1659 by 2212 pixels: 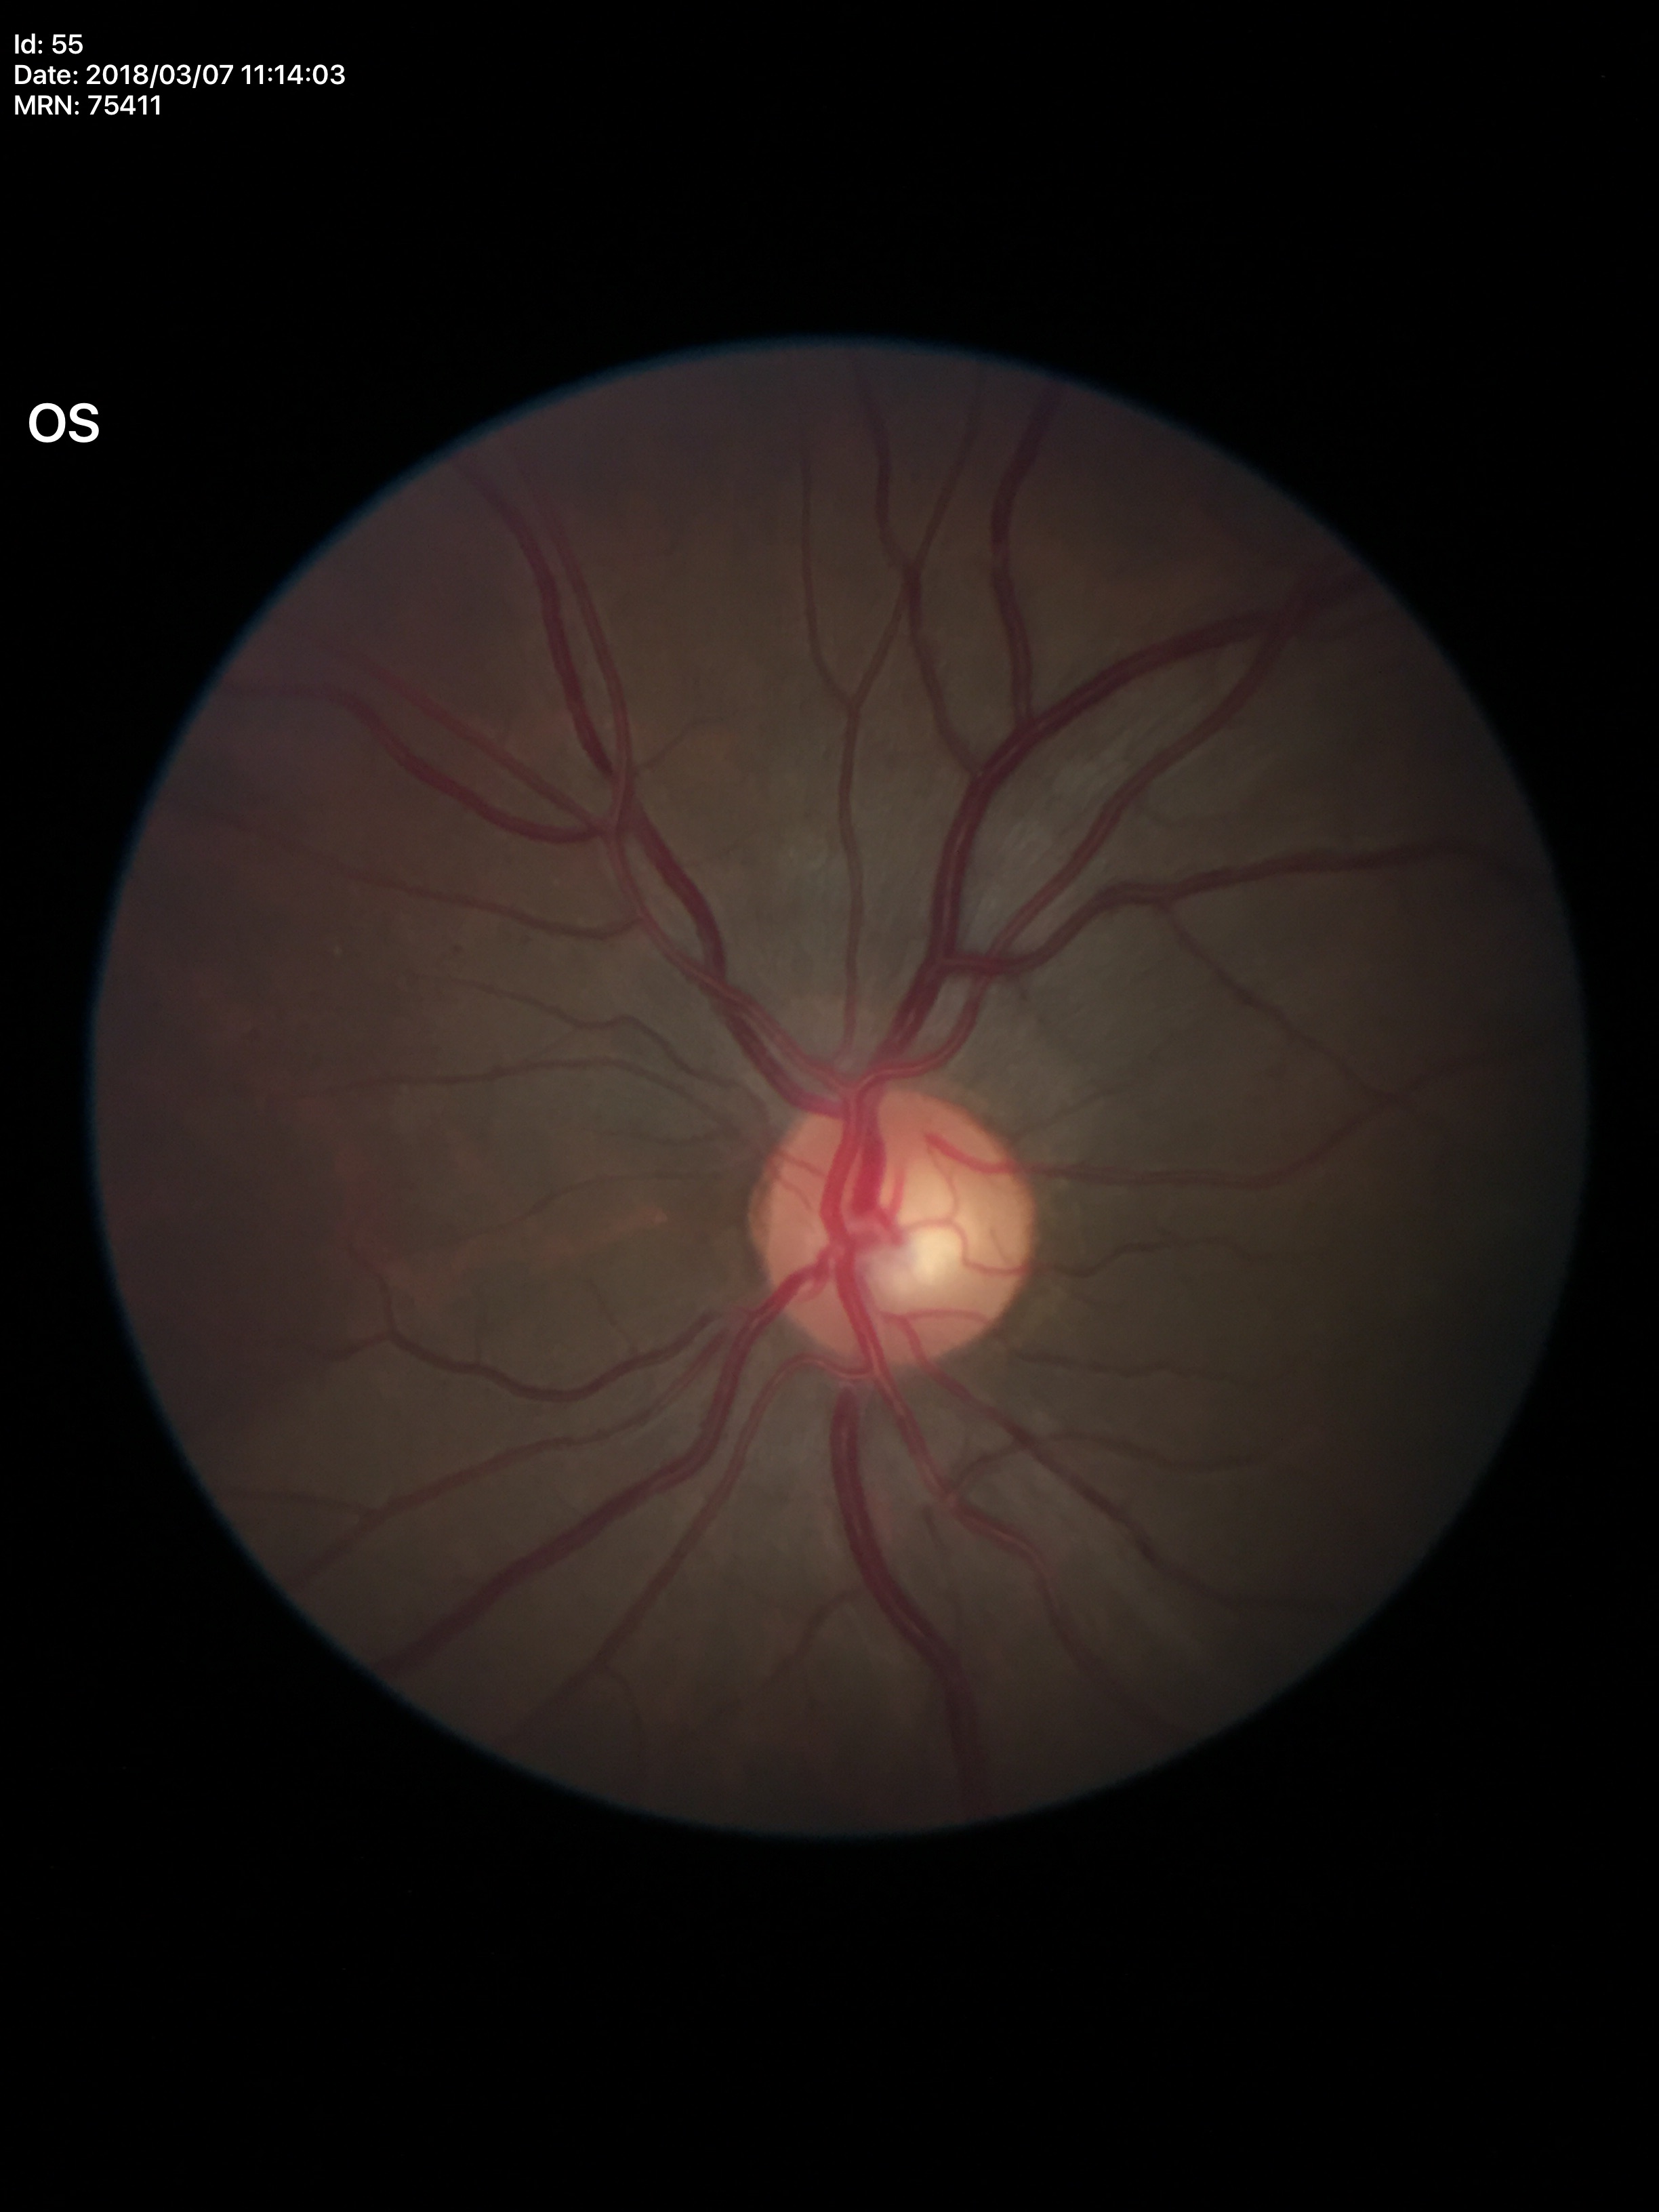
Glaucoma evaluation: no suspicious findings, vertical cup-disc ratio: 0.56.